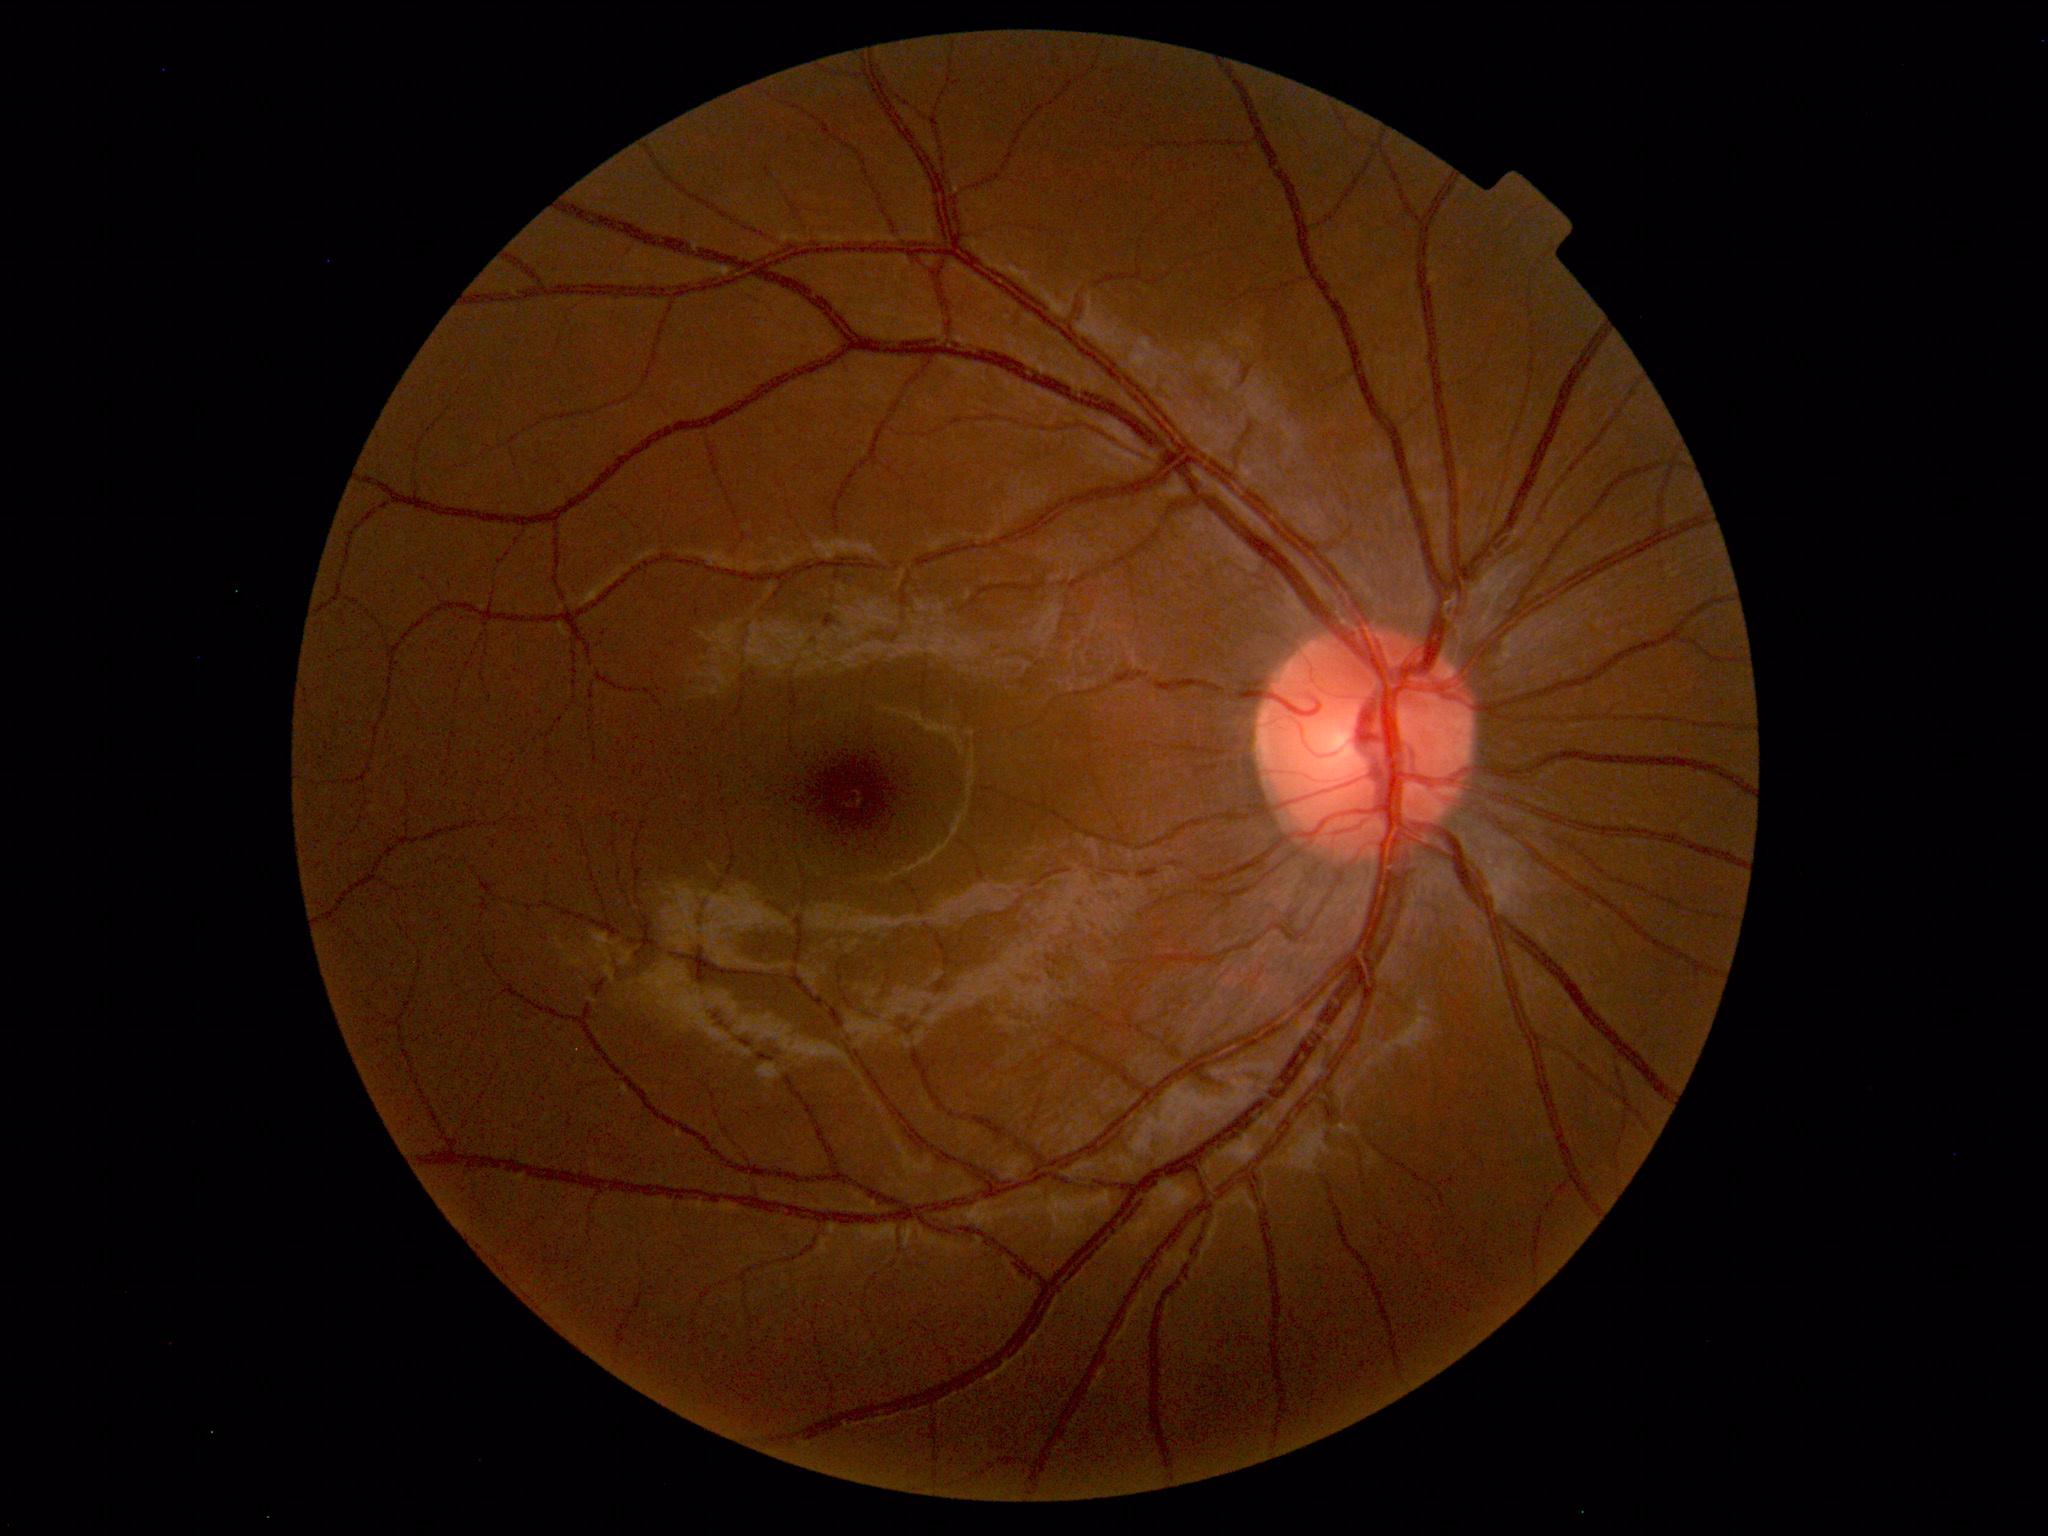

Within normal limits. No abnormalities identified.